2361 x 1568 pixels.
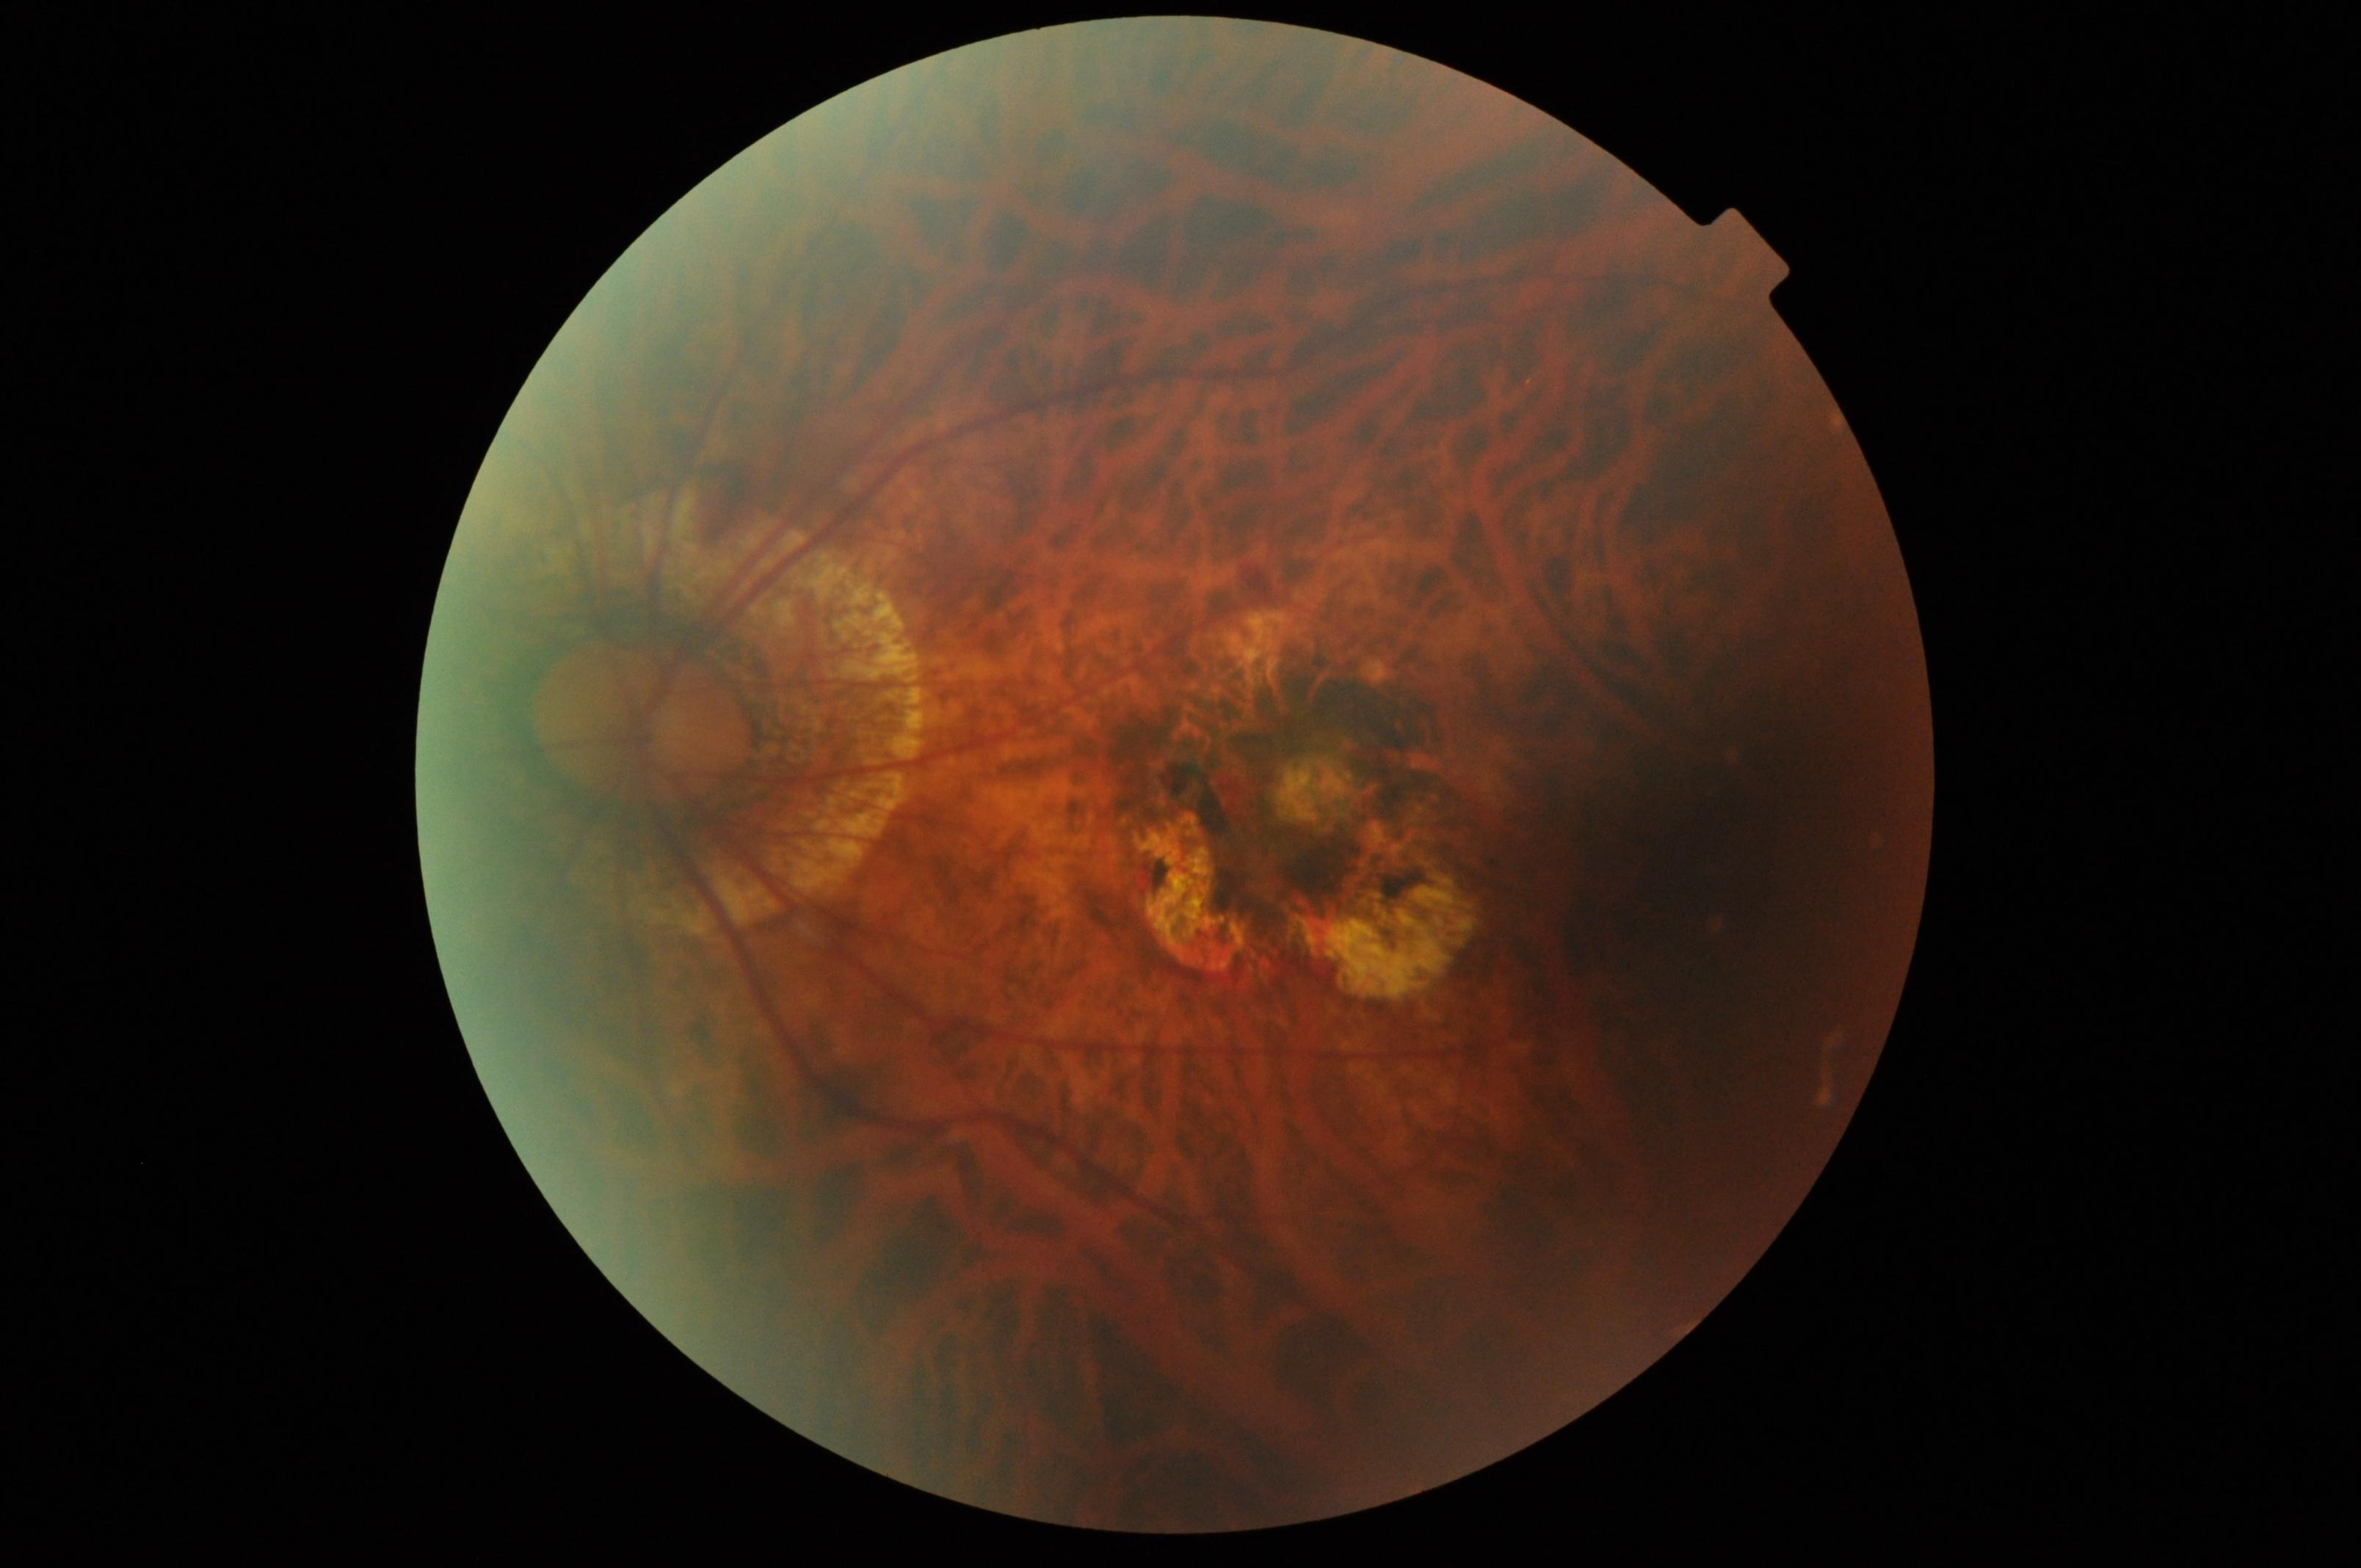

Consistent with pathological myopia.